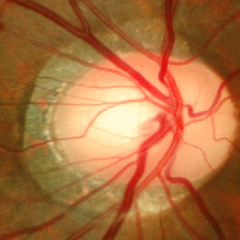 Color fundus photograph showing early-stage glaucoma.